50° FOV:
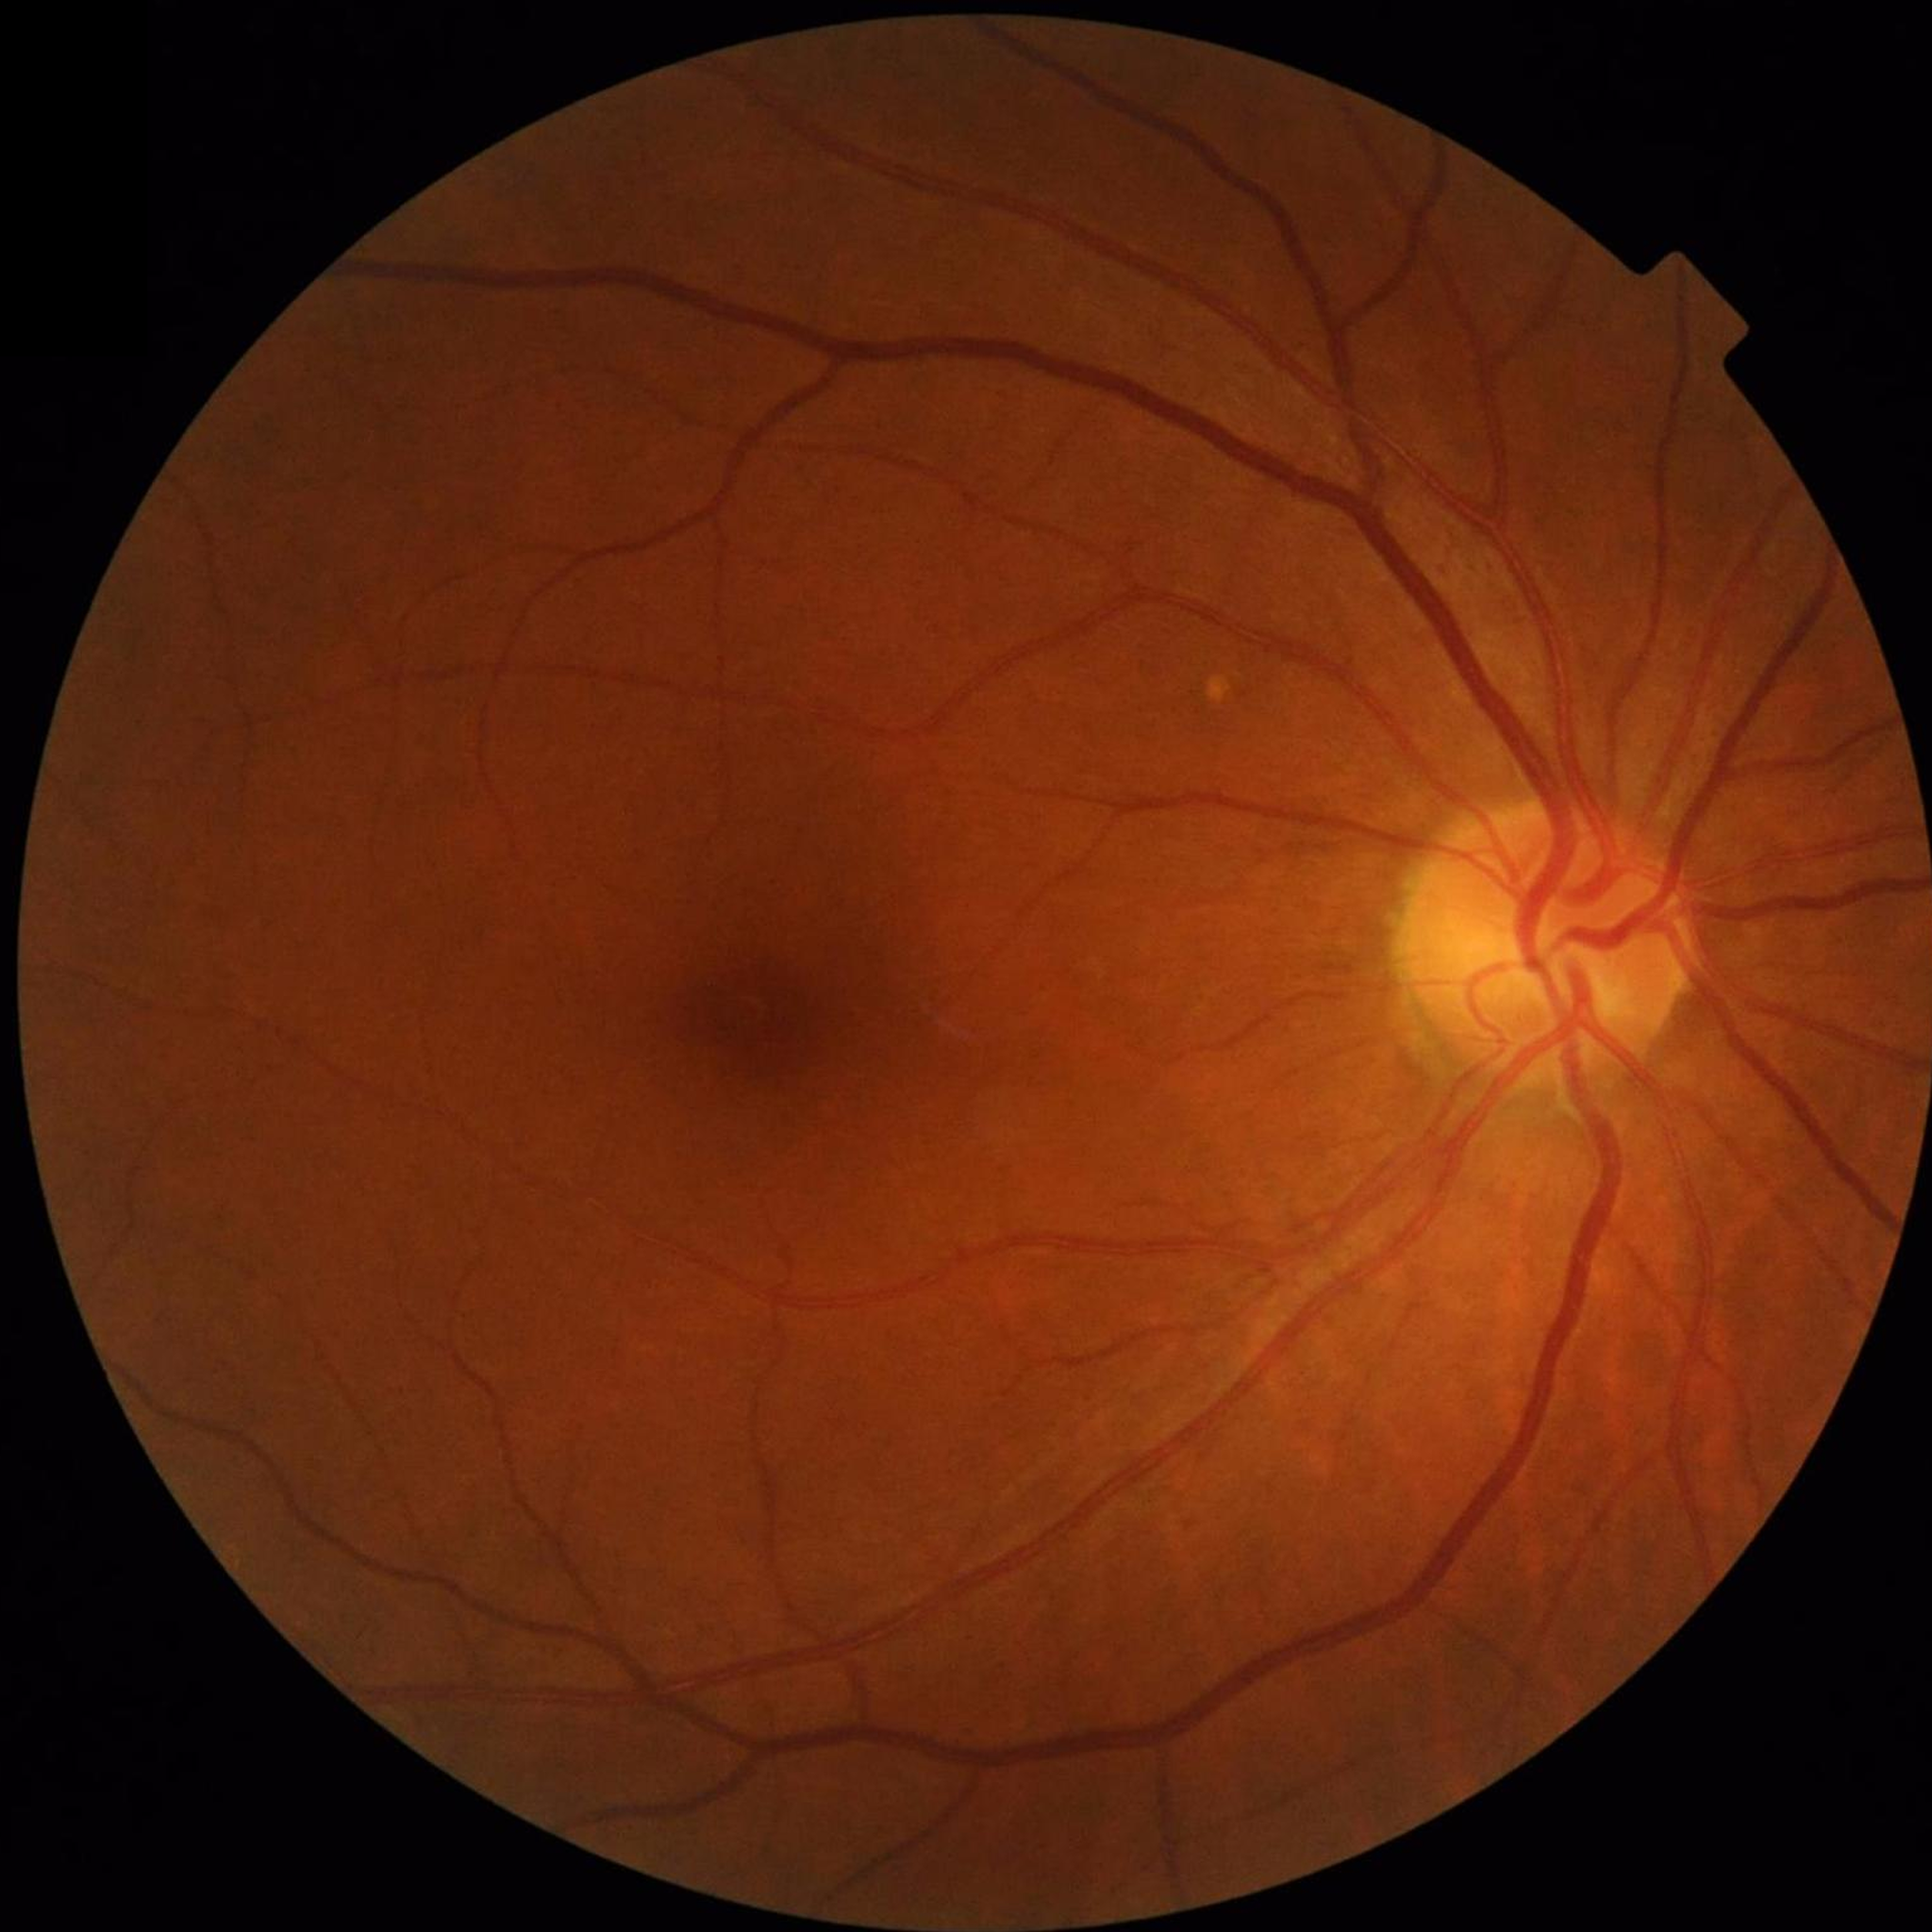 Image quality: adequate.
Fundus image with no AMD, diabetic retinopathy, or glaucomatous findings.